1932x1916px, CFP:
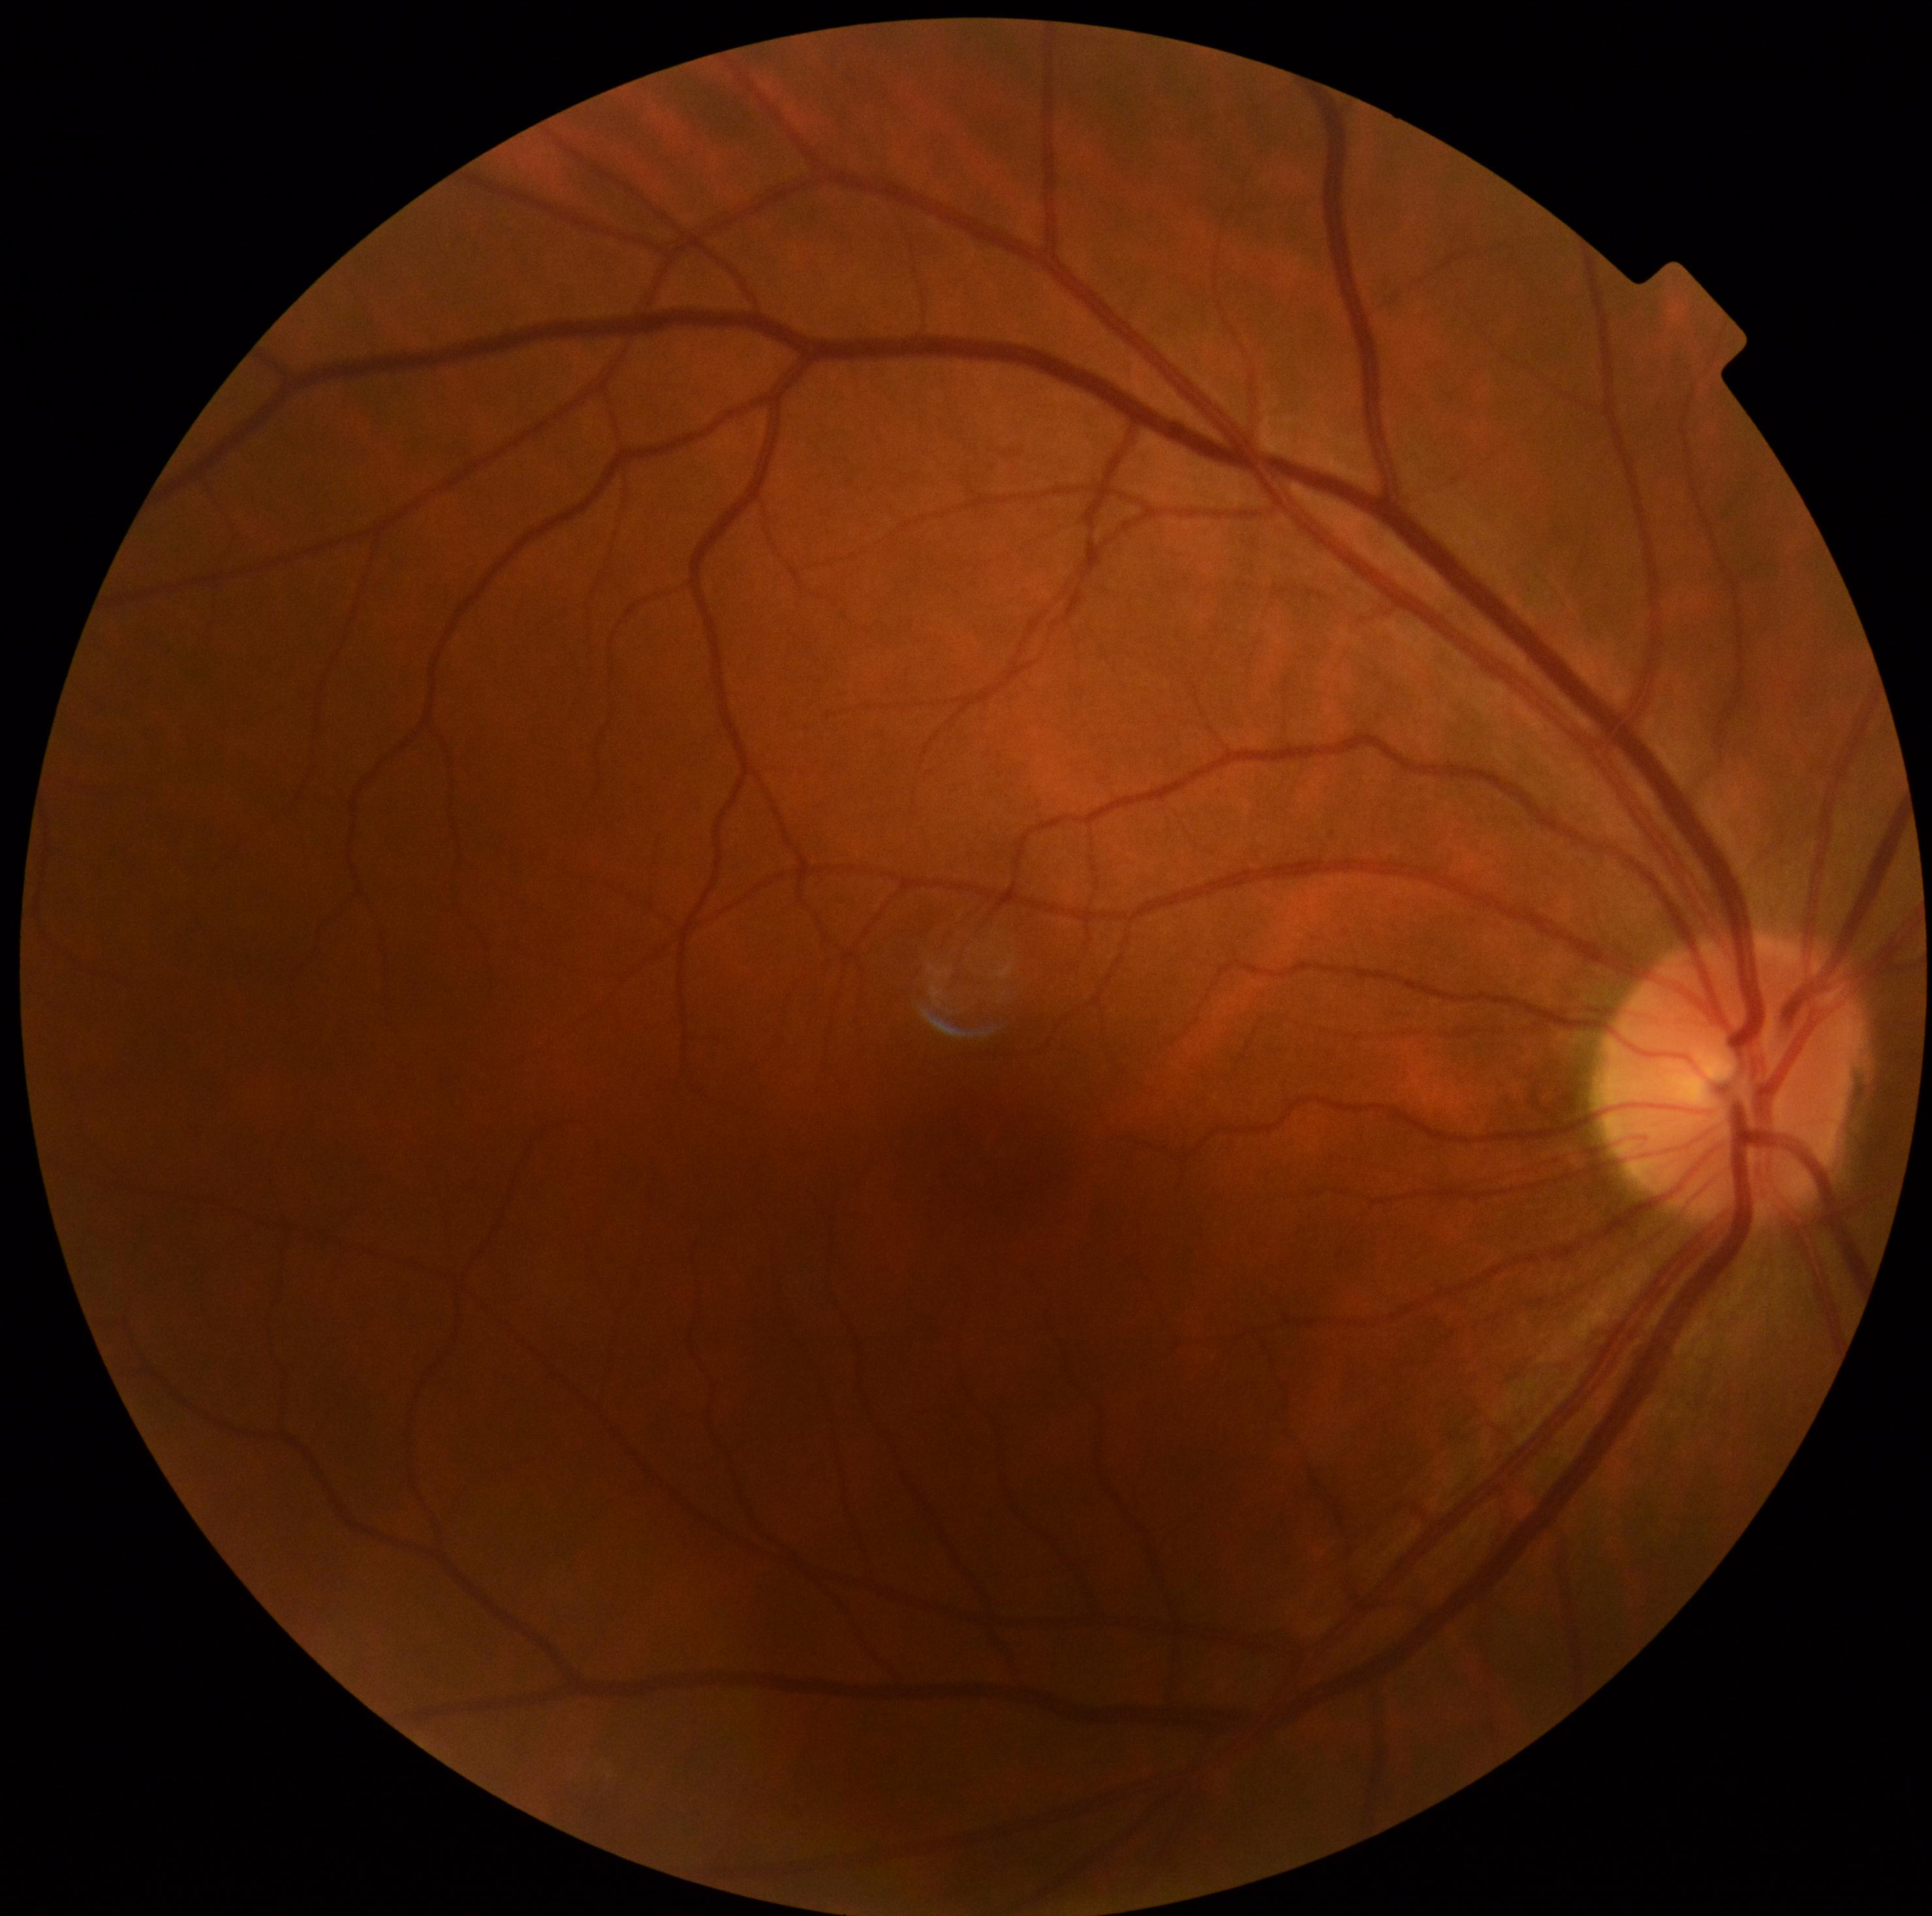
DR stage is grade 0 (no apparent retinopathy).